Wide-field contact fundus photograph of an infant · acquired on the Phoenix ICON · 1240x1240: 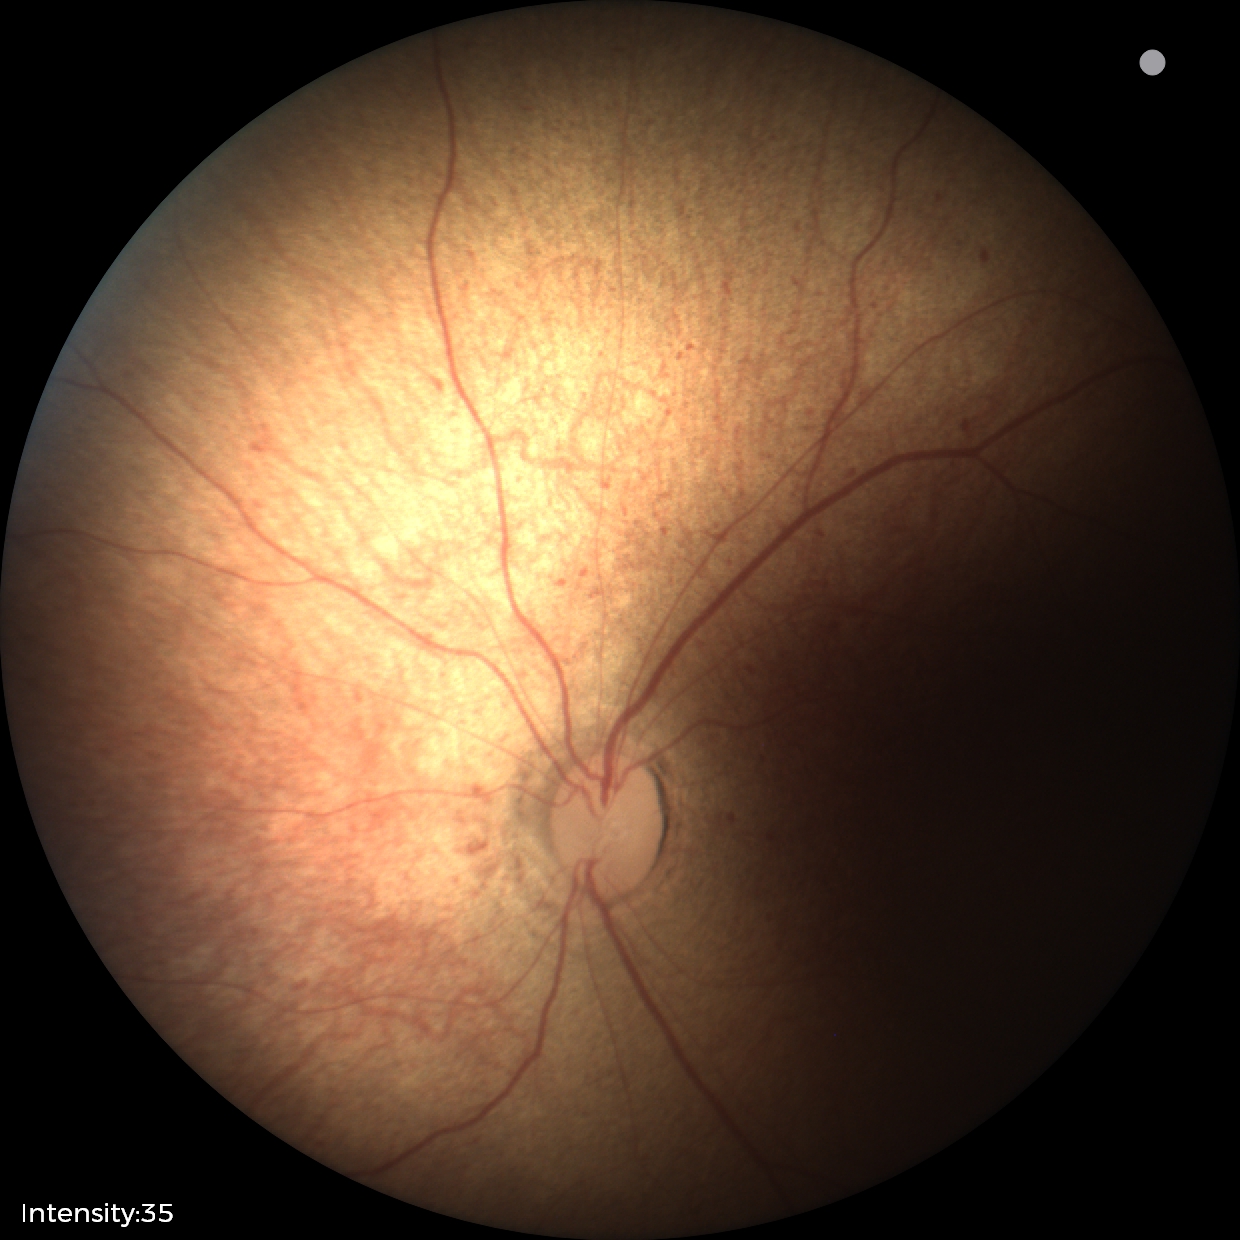

Examination with physiological retinal findings.